Image size 2212x1659; 45° field of view; color fundus photograph.
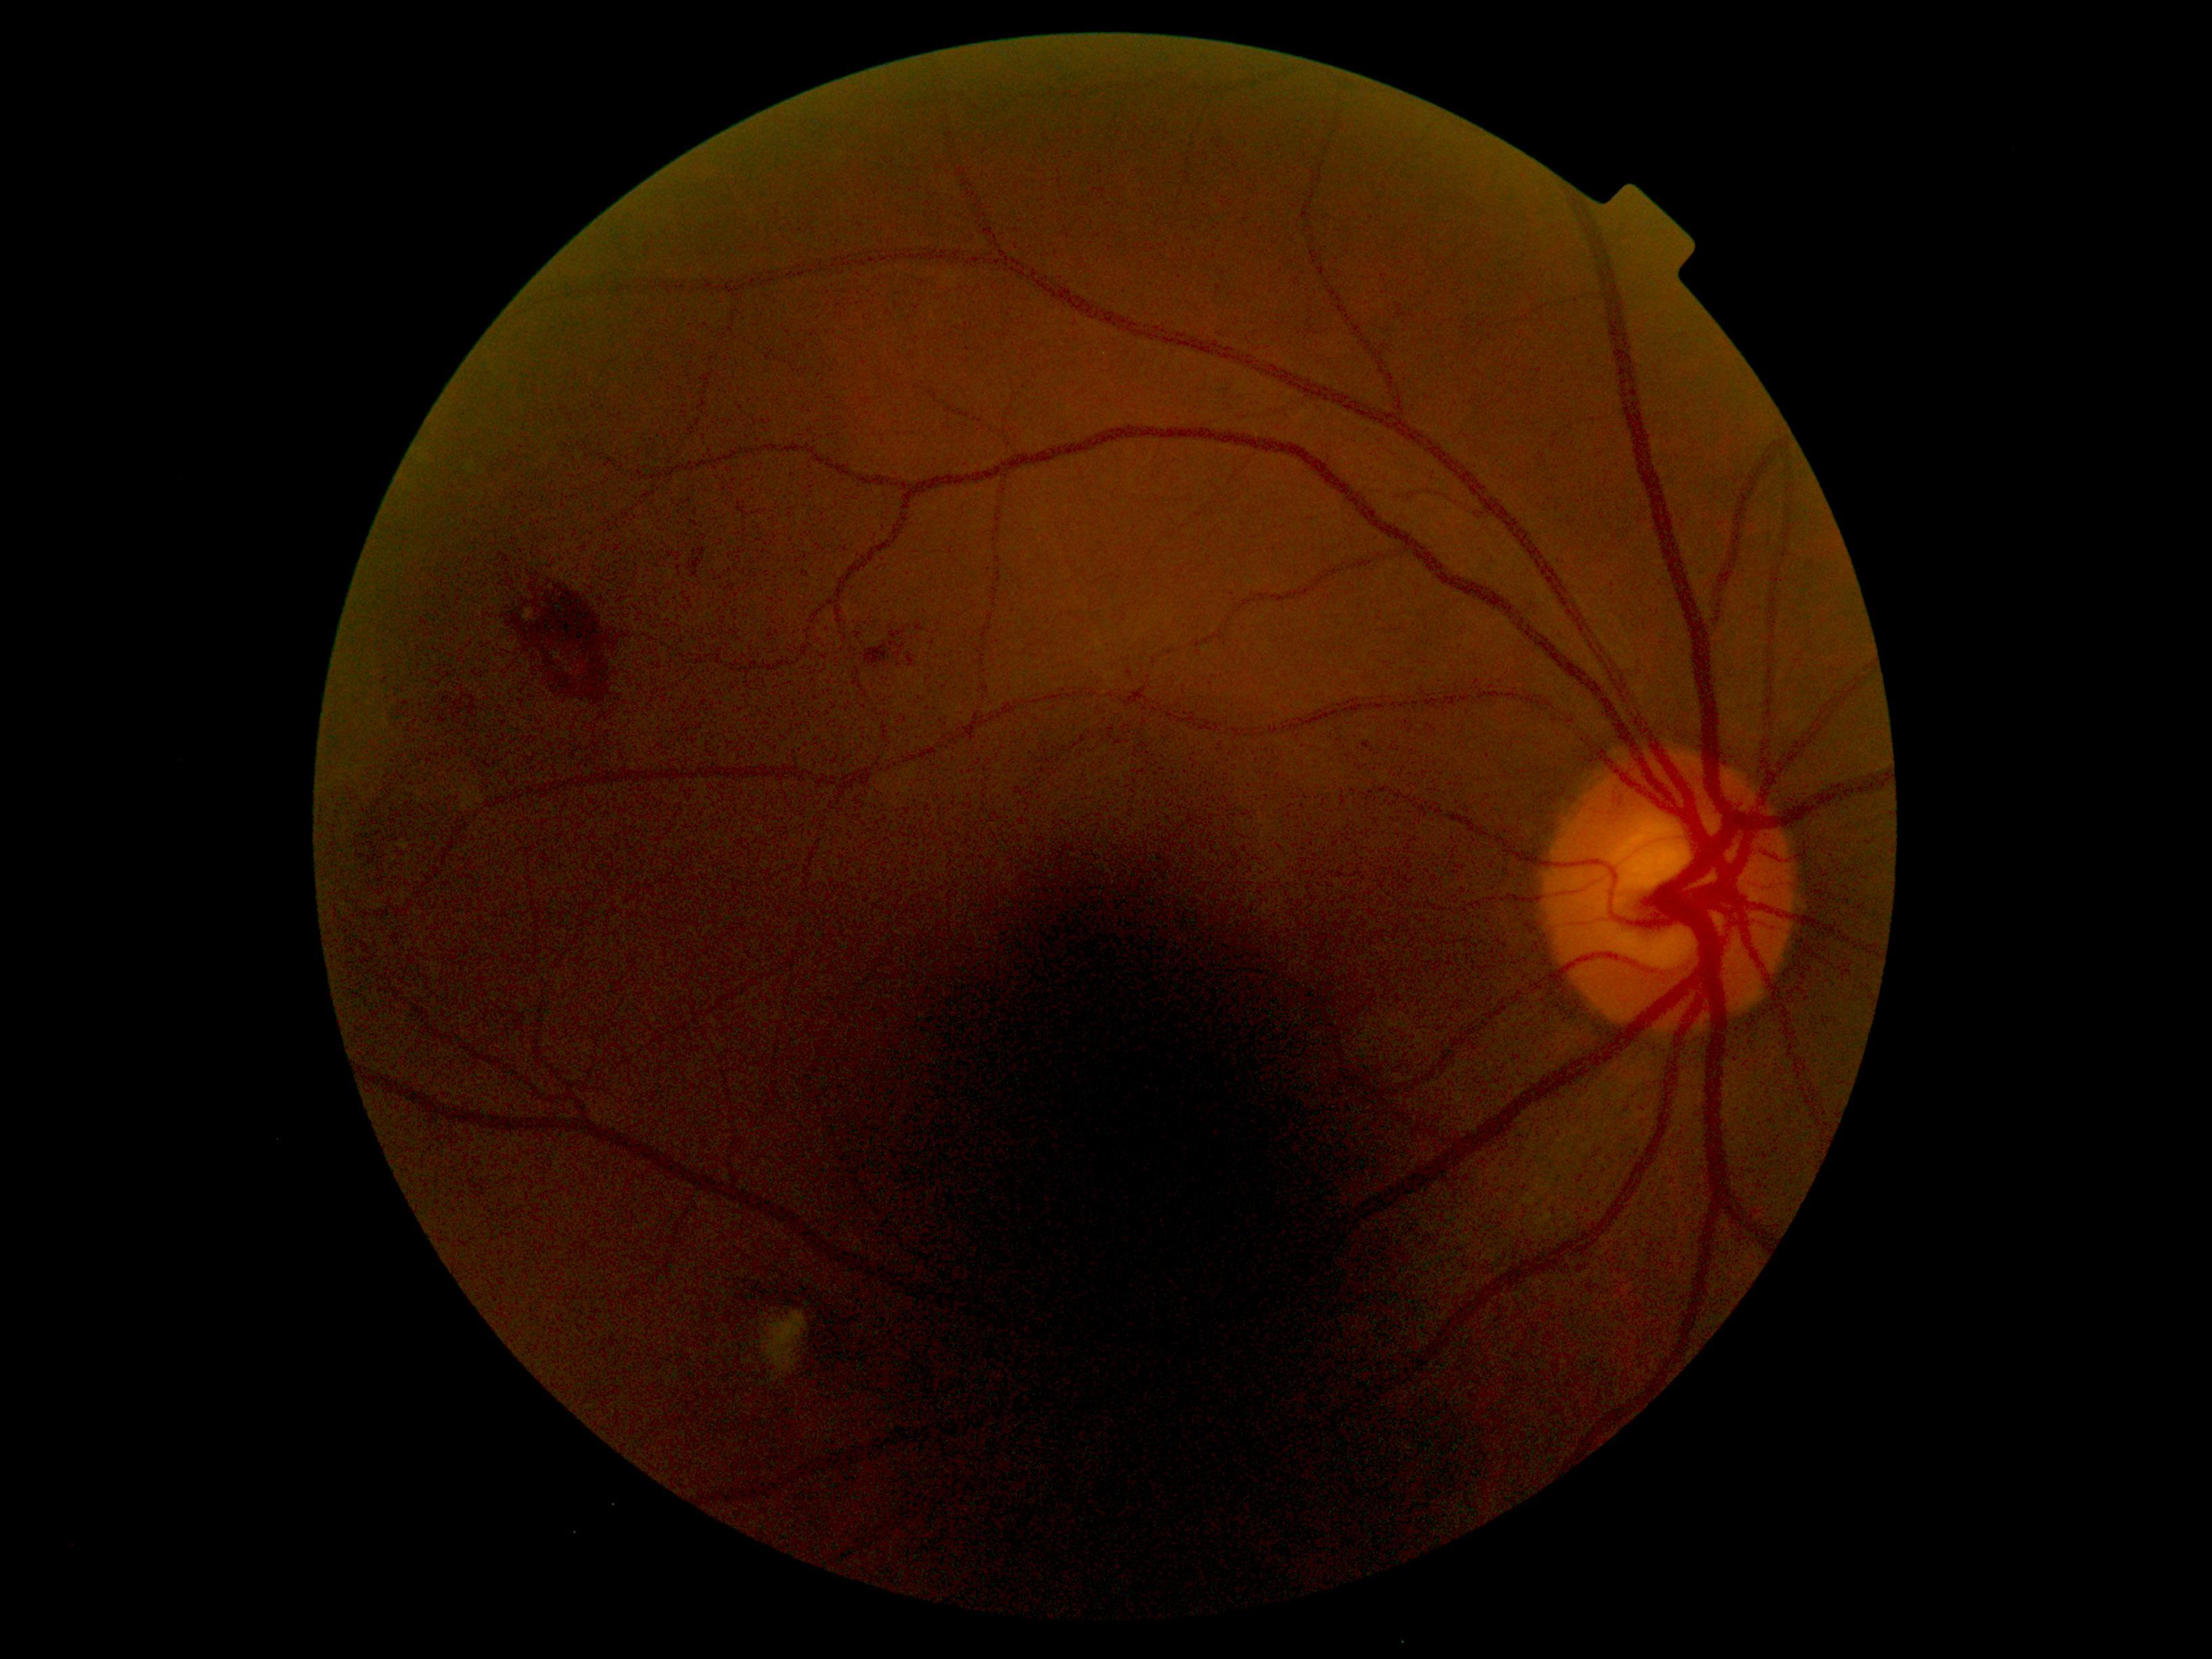

Diabetic retinopathy (DR): grade 2 (moderate NPDR).